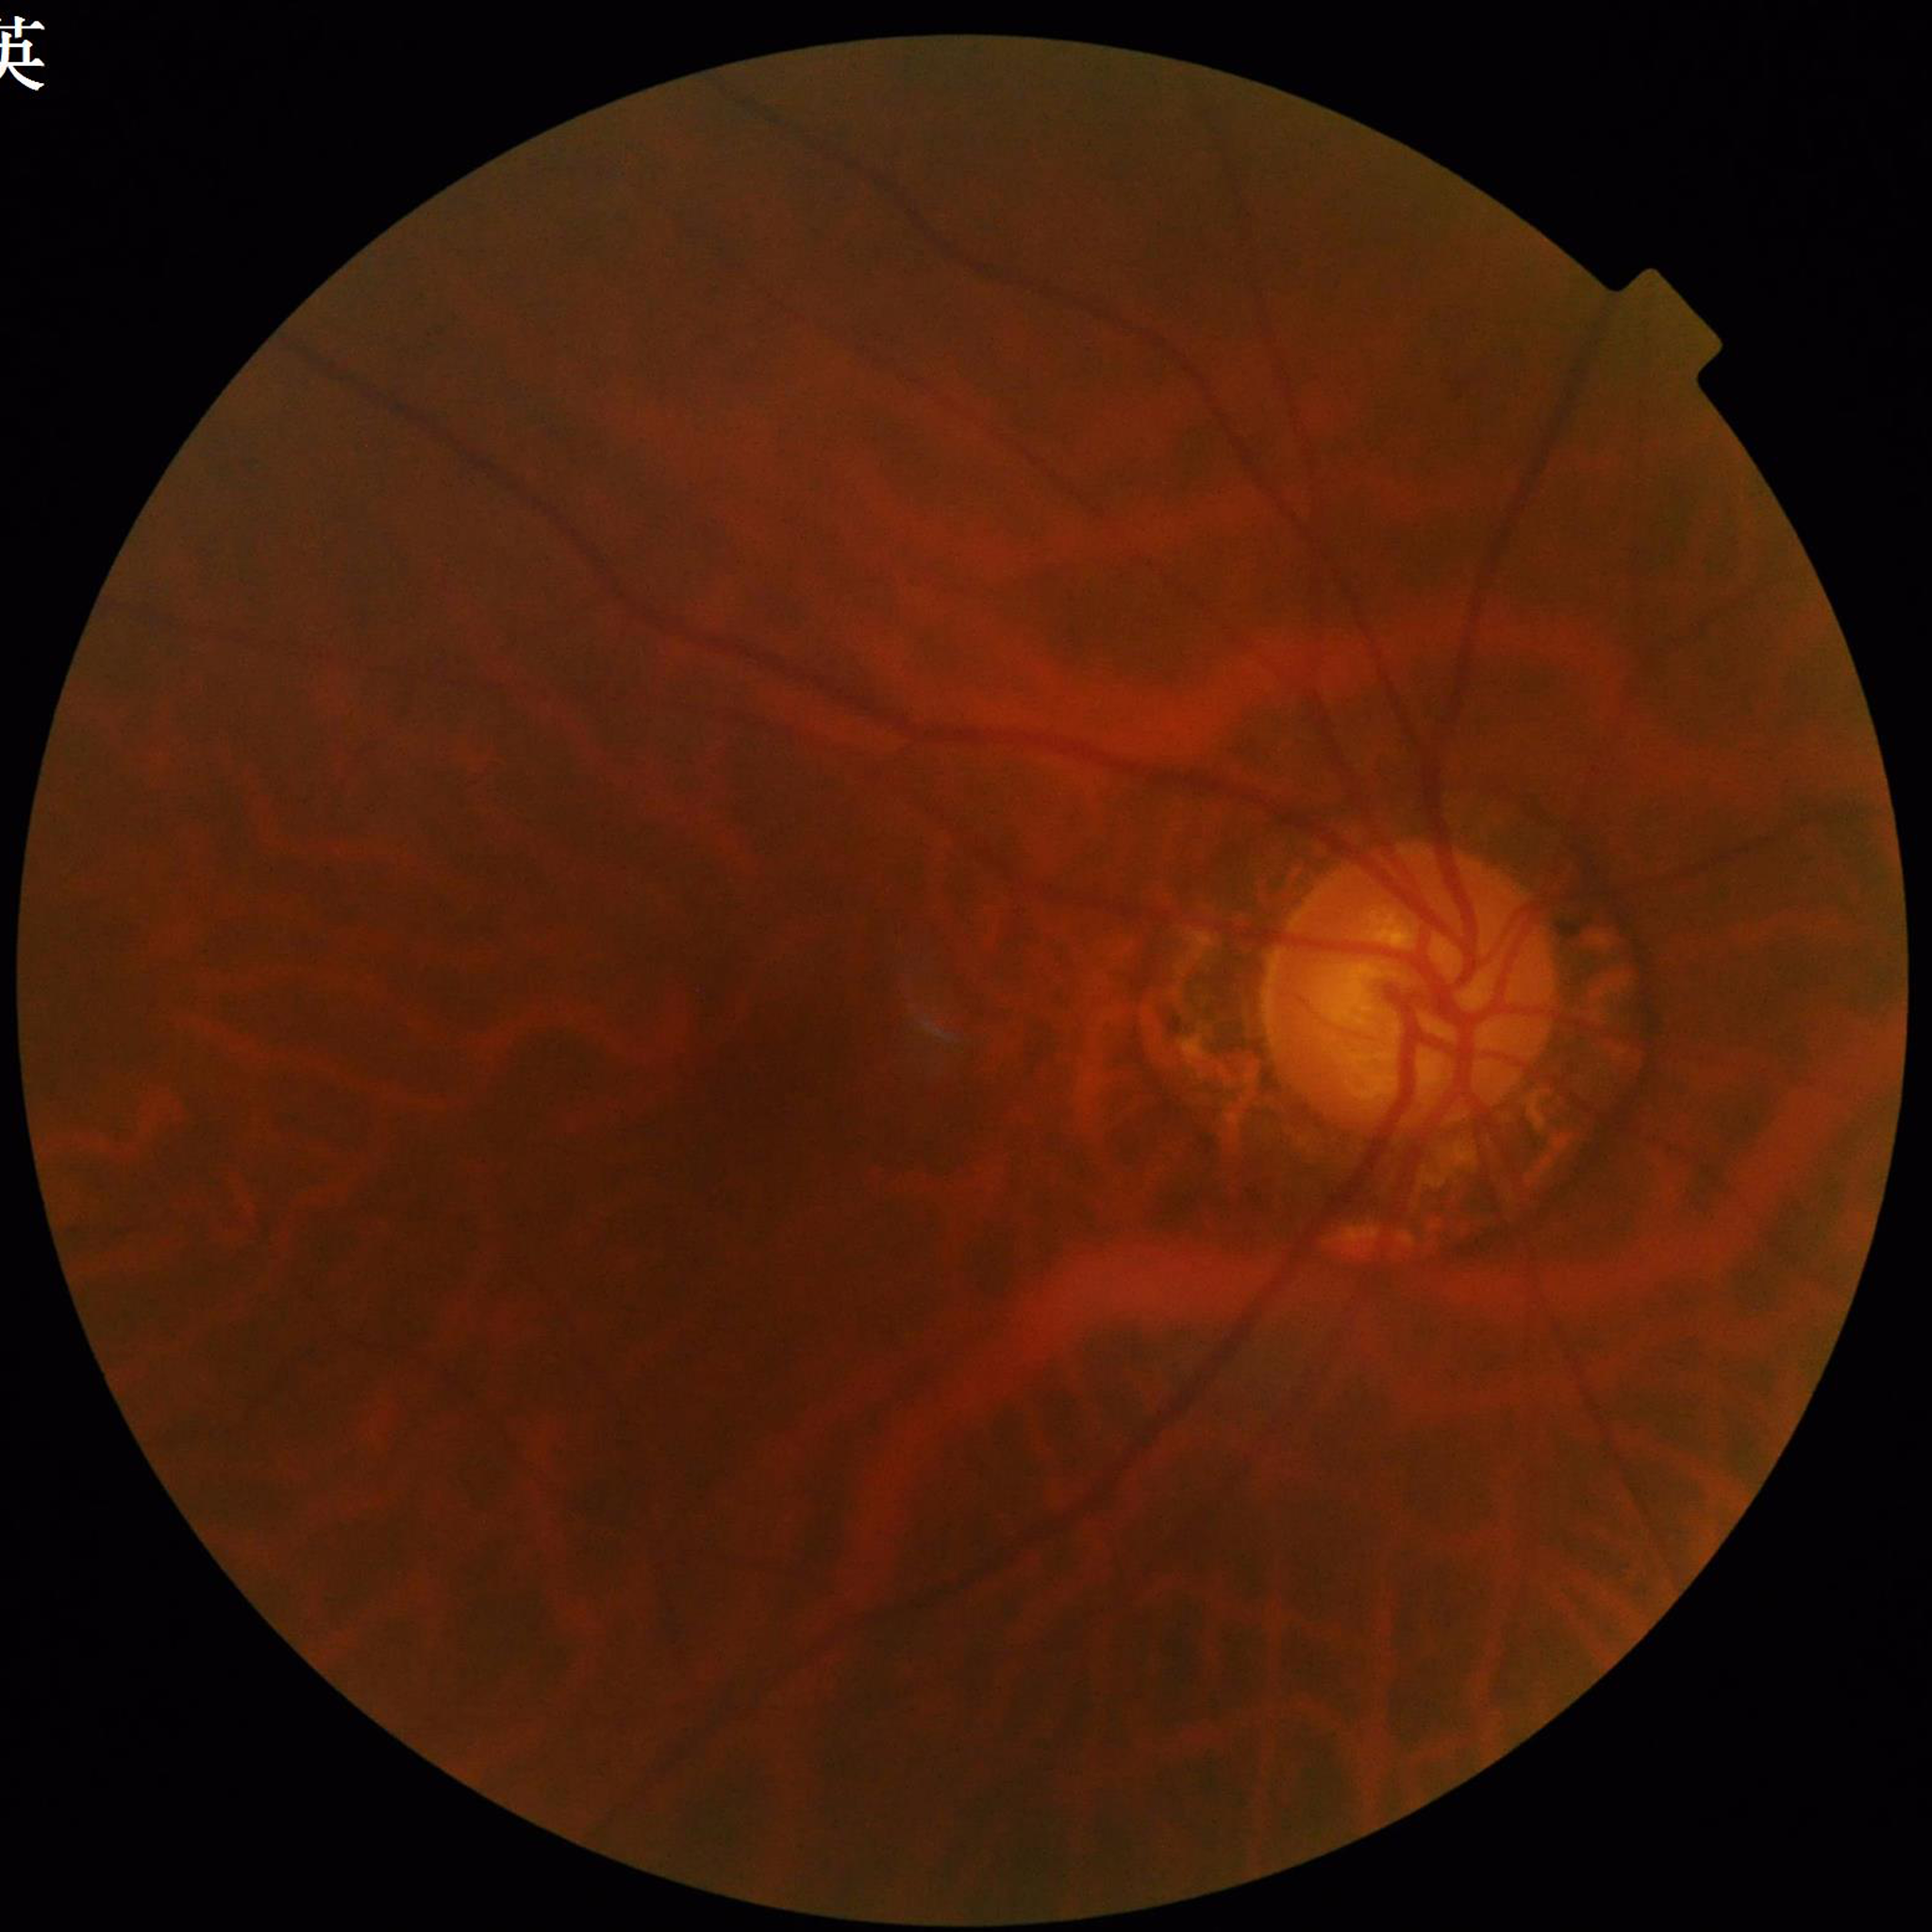

Clinical diagnosis: diabetic retinopathy | Photo quality: suboptimal — blur, illumination/color distortion.